Color fundus image, 2352 by 1568 pixels:
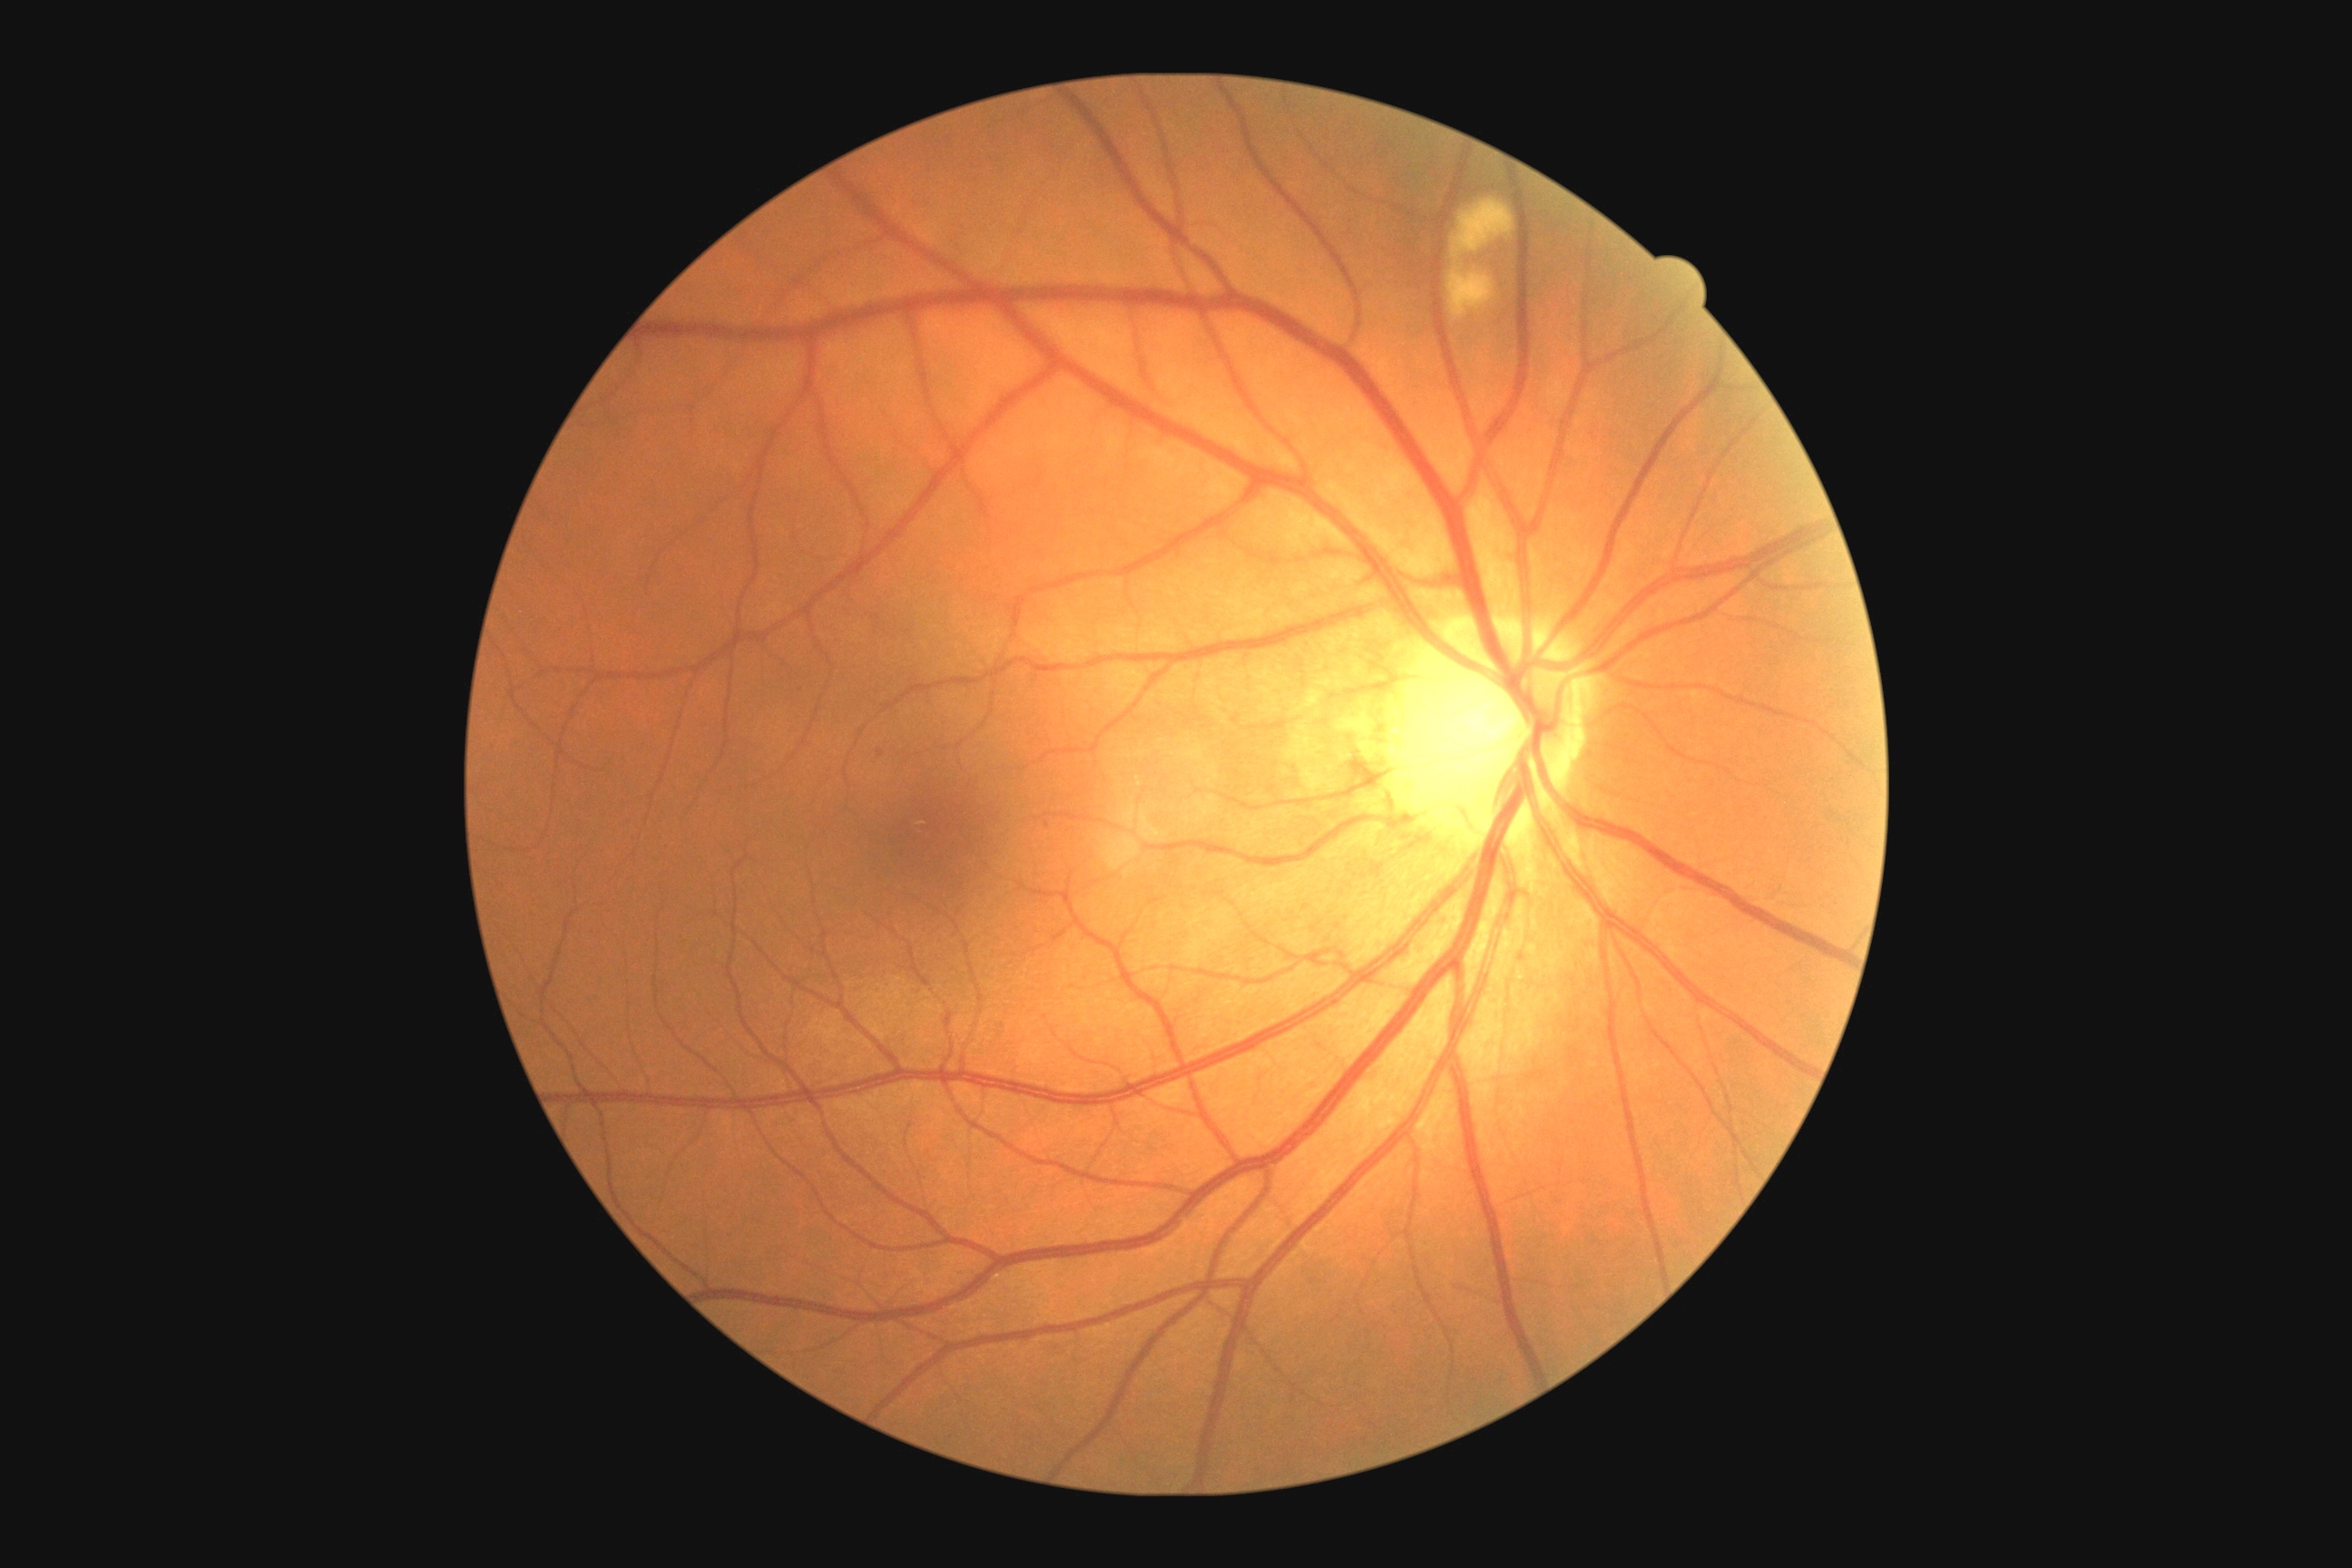

Disease class: non-proliferative diabetic retinopathy.
DR: 2.